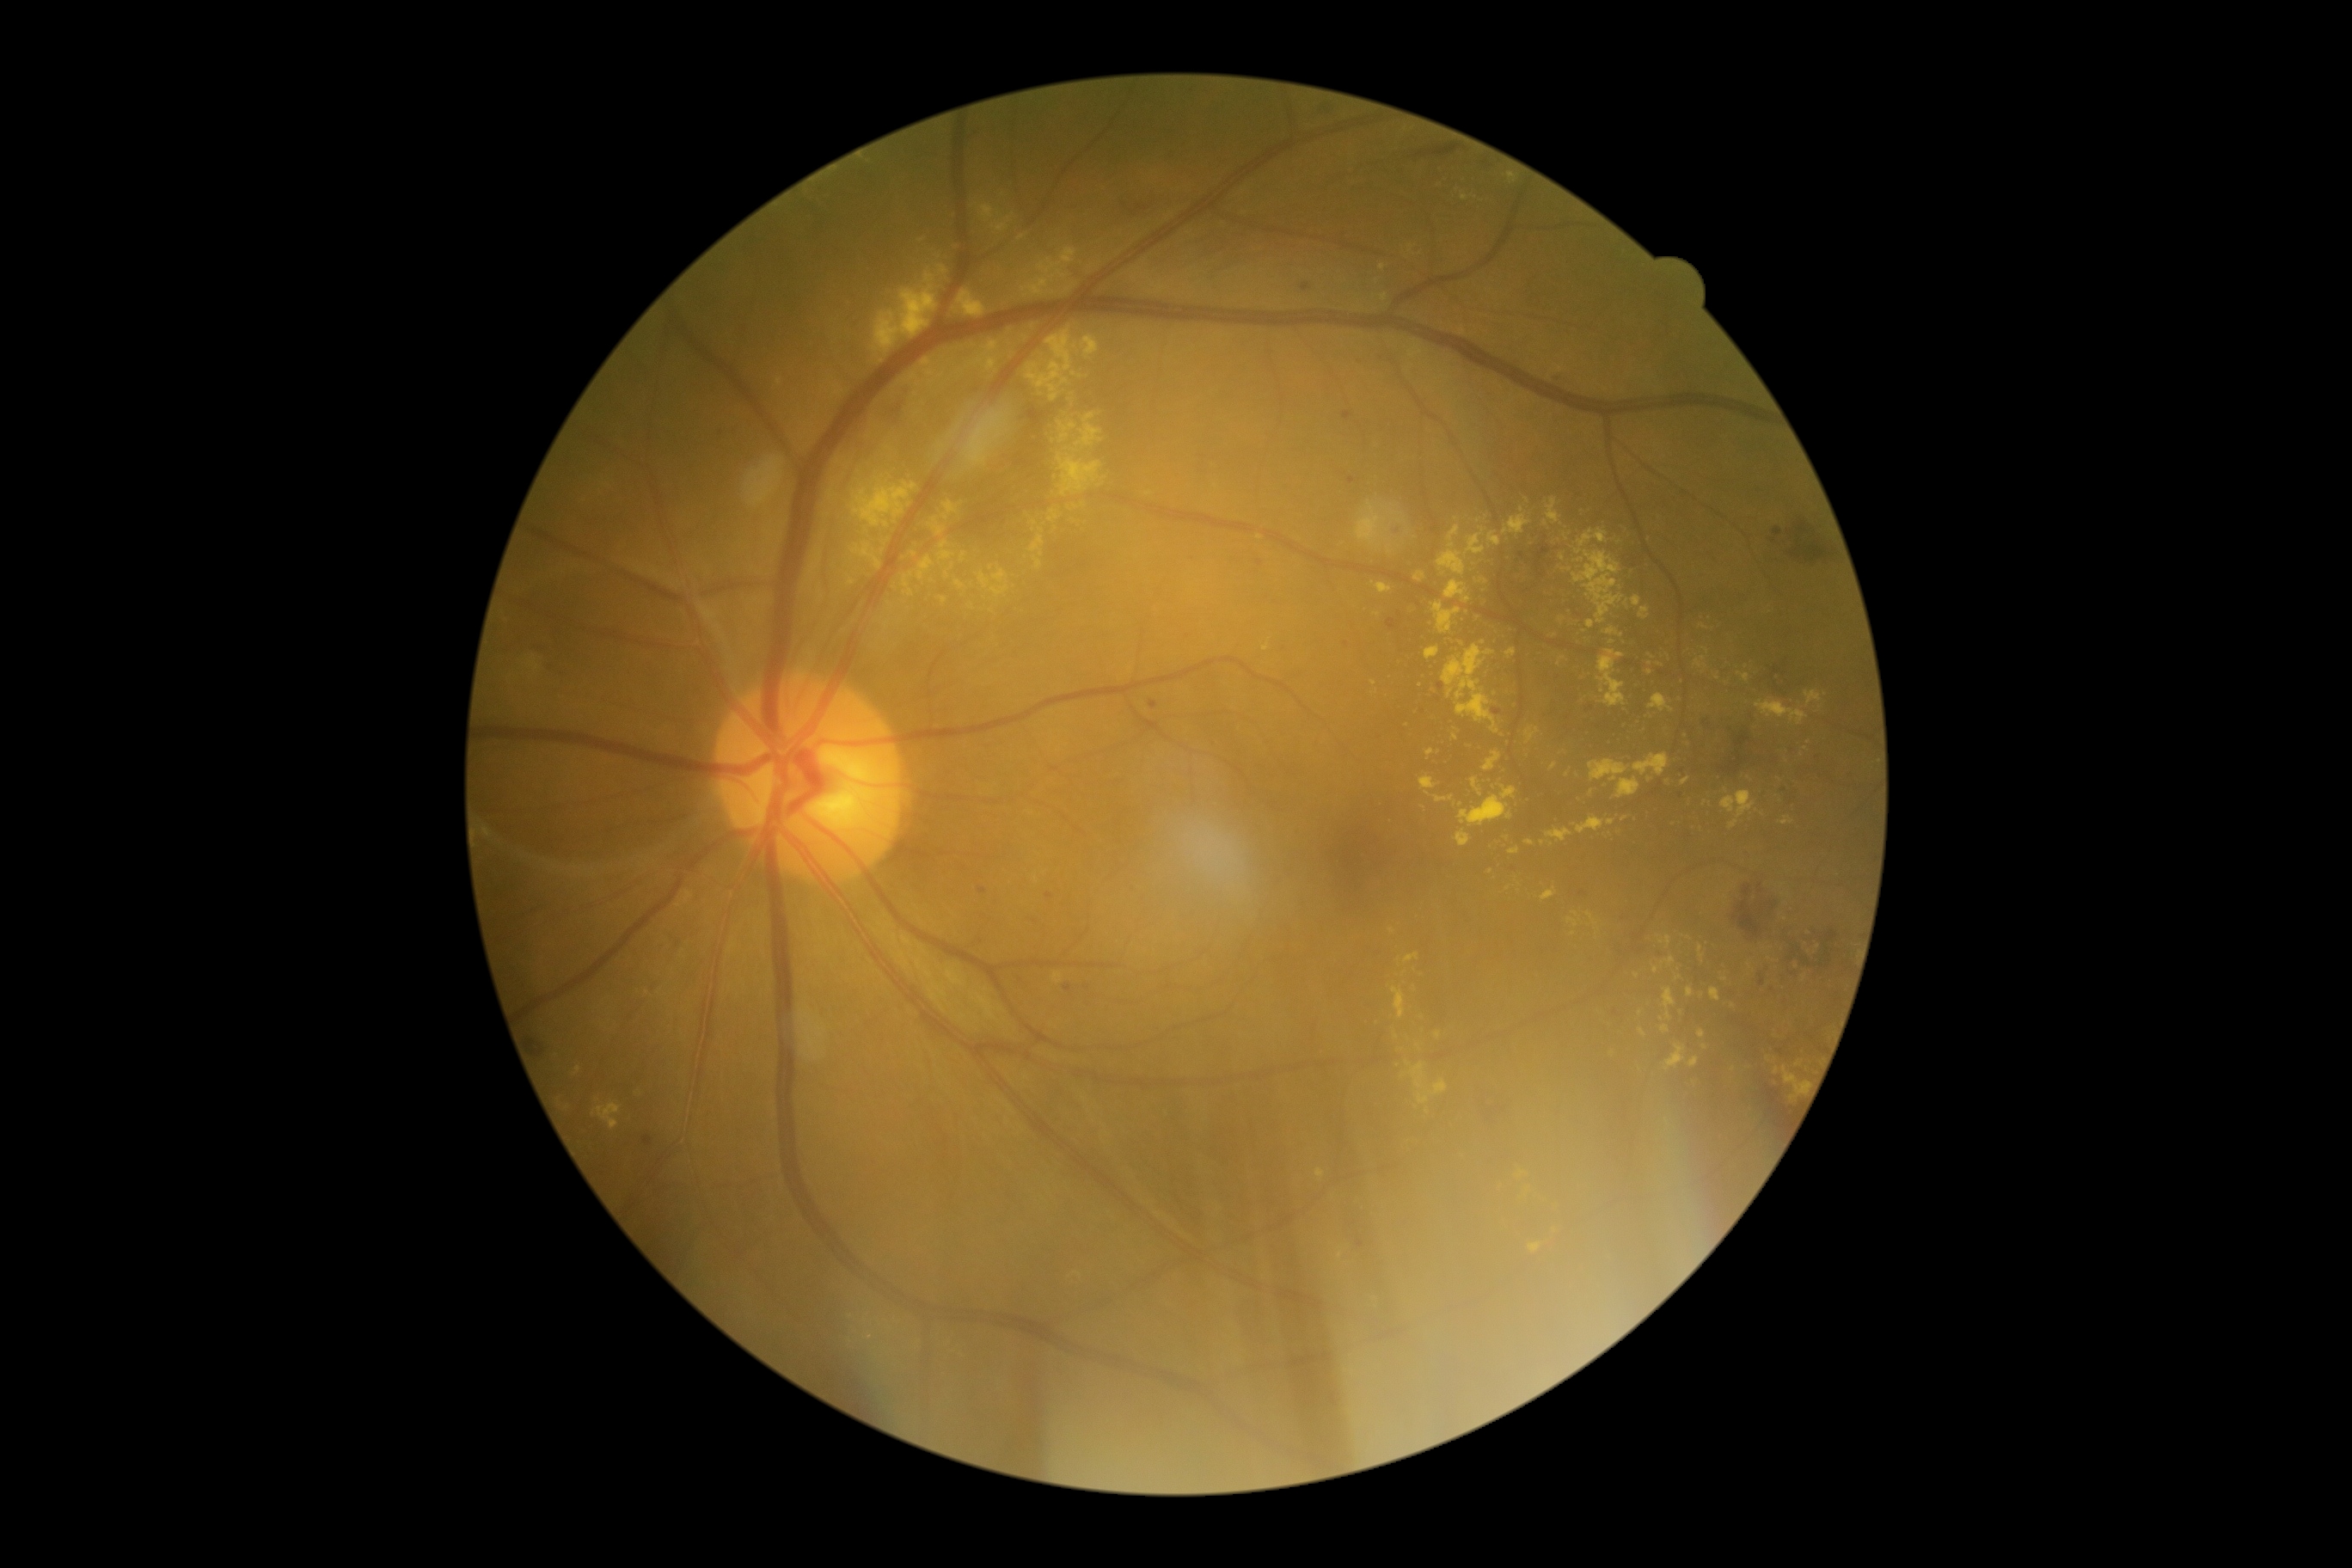
{"partial": true, "dr_grade": 2, "dr_grade_name": "moderate NPDR", "lesions": {"se": null, "ma": [[1552, 372, 1564, 383], [644, 1136, 654, 1148], [1149, 701, 1158, 711], [1046, 891, 1053, 900], [1493, 709, 1502, 716], [1356, 1239, 1364, 1249], [1347, 477, 1356, 484], [979, 886, 988, 895], [1302, 283, 1311, 291], [1063, 984, 1072, 993], [1344, 412, 1352, 420]], "ma_small_centers": [[1514, 869], [1440, 686], [1354, 1223], [1347, 644], [1582, 894], [1591, 707]], "ex": [[957, 290, 988, 317], [1526, 840, 1534, 847], [1596, 651, 1626, 707], [1710, 988, 1720, 1001], [1605, 627, 1624, 637], [1507, 173, 1517, 183], [940, 266, 948, 274], [1545, 828, 1572, 842], [1574, 818, 1605, 835], [922, 360, 936, 377], [1026, 328, 1099, 403]], "ex_small_centers": [[567, 1108], [1397, 1036], [597, 1099], [1545, 524], [1134, 279], [1509, 888], [1637, 975], [1409, 1063], [827, 515]], "he": [[1724, 749, 1749, 775], [1803, 957, 1811, 965], [1615, 931, 1674, 959], [1122, 204, 1149, 216], [1017, 455, 1029, 467], [1758, 883, 1763, 893], [1734, 885, 1763, 938], [1767, 902, 1777, 910], [1027, 408, 1046, 429], [864, 377, 916, 441], [1822, 950, 1834, 969], [1736, 732, 1751, 747], [1760, 974, 1765, 988]], "he_small_centers": [[1772, 990], [1785, 790], [1790, 959]]}}